NIDEK AFC-230 fundus camera · nonmydriatic
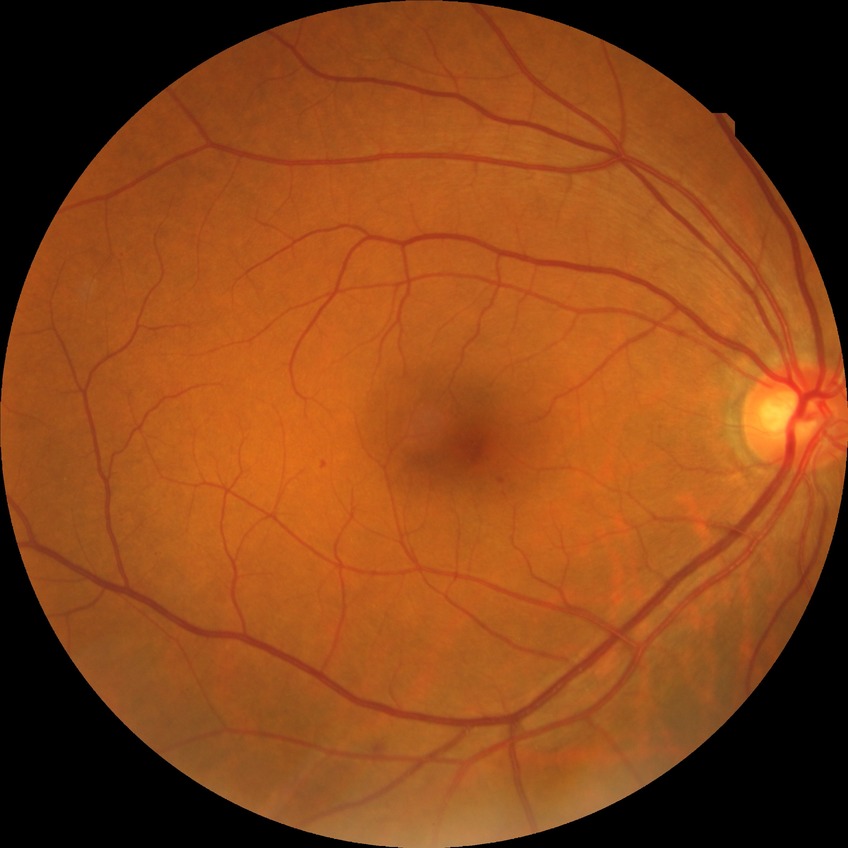
Davis grading: simple diabetic retinopathy.